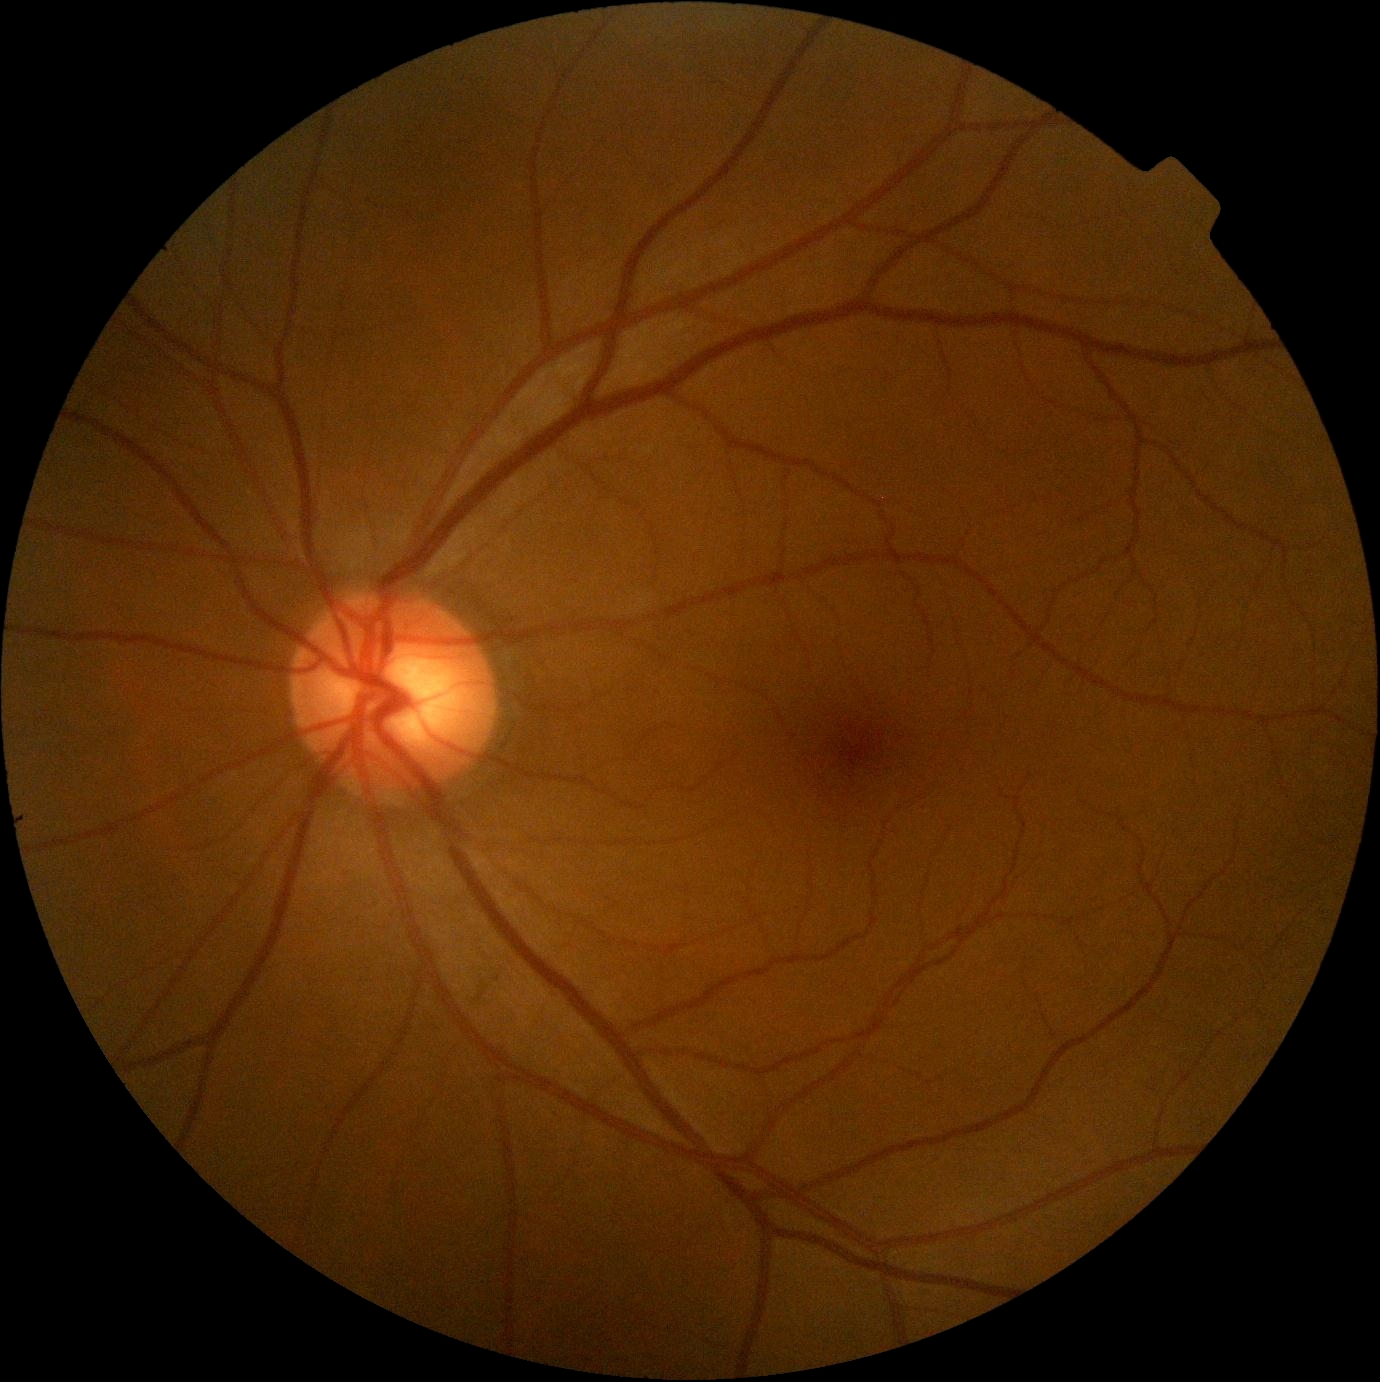

Retinopathy grade: no apparent retinopathy (0).